Fundus photo
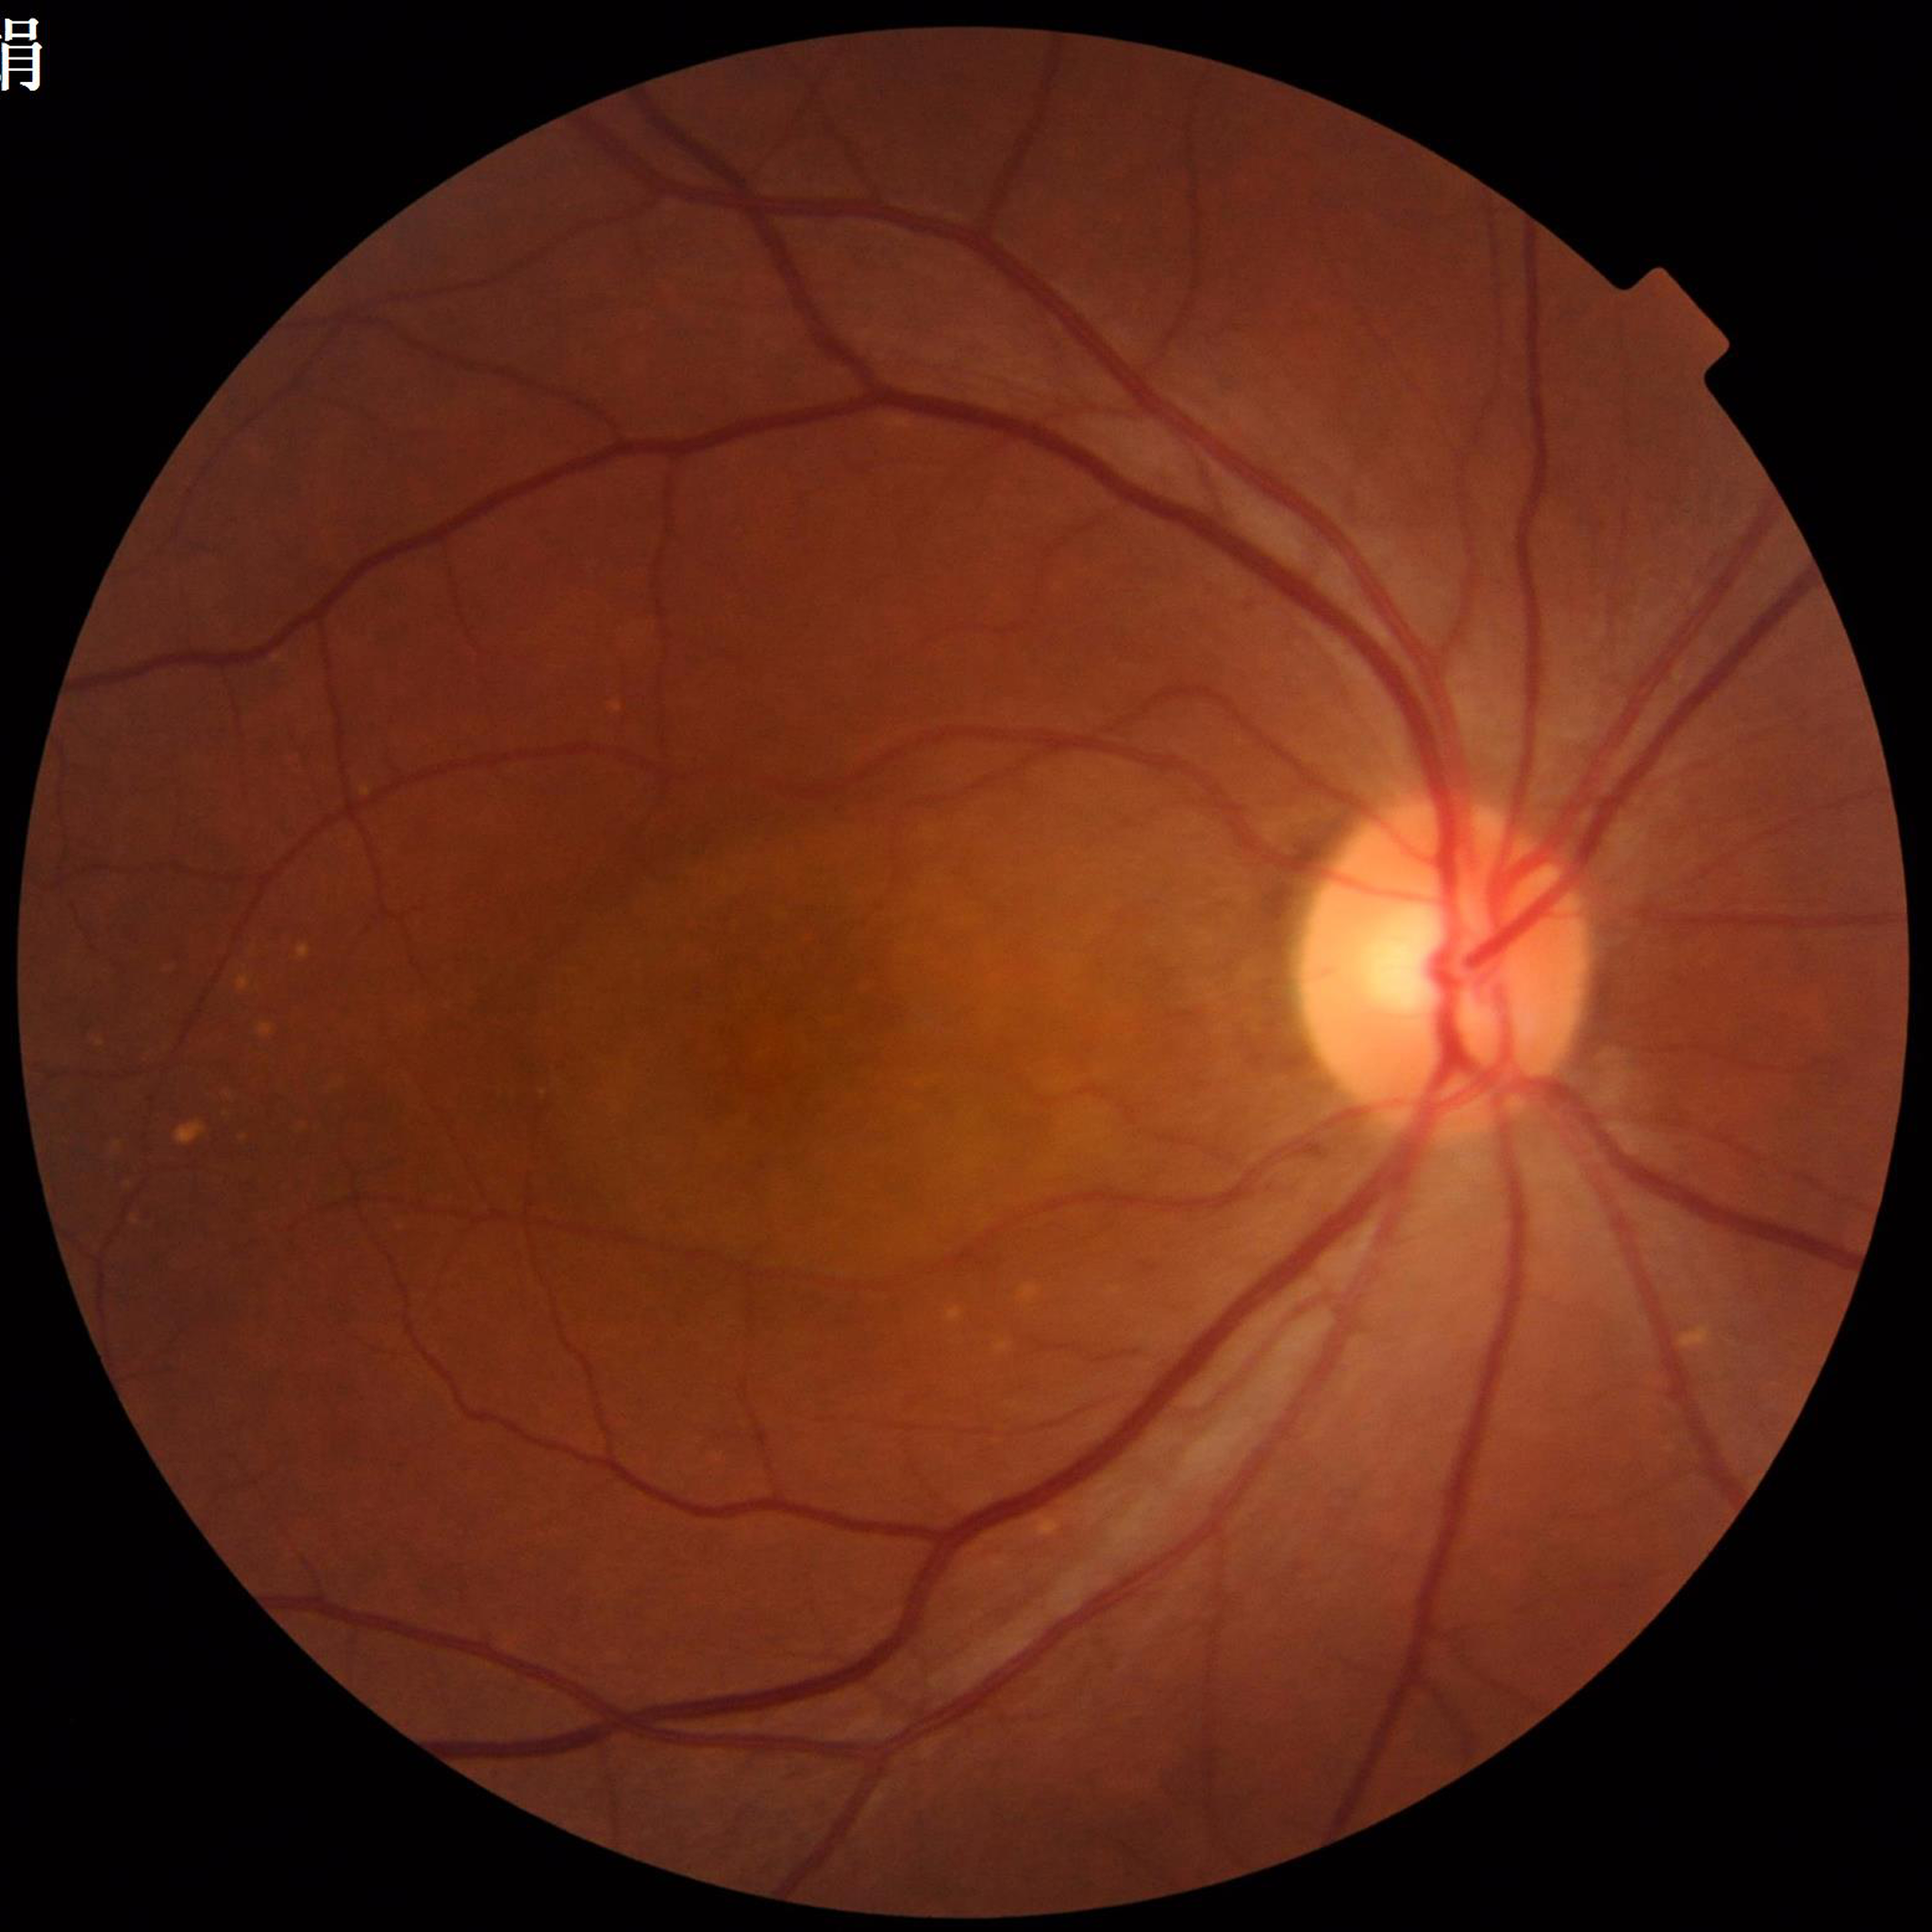
  image_quality: satisfactory
  diagnosis: age-related macular degeneration